Wide-field fundus photograph of an infant. 1240x1240px: 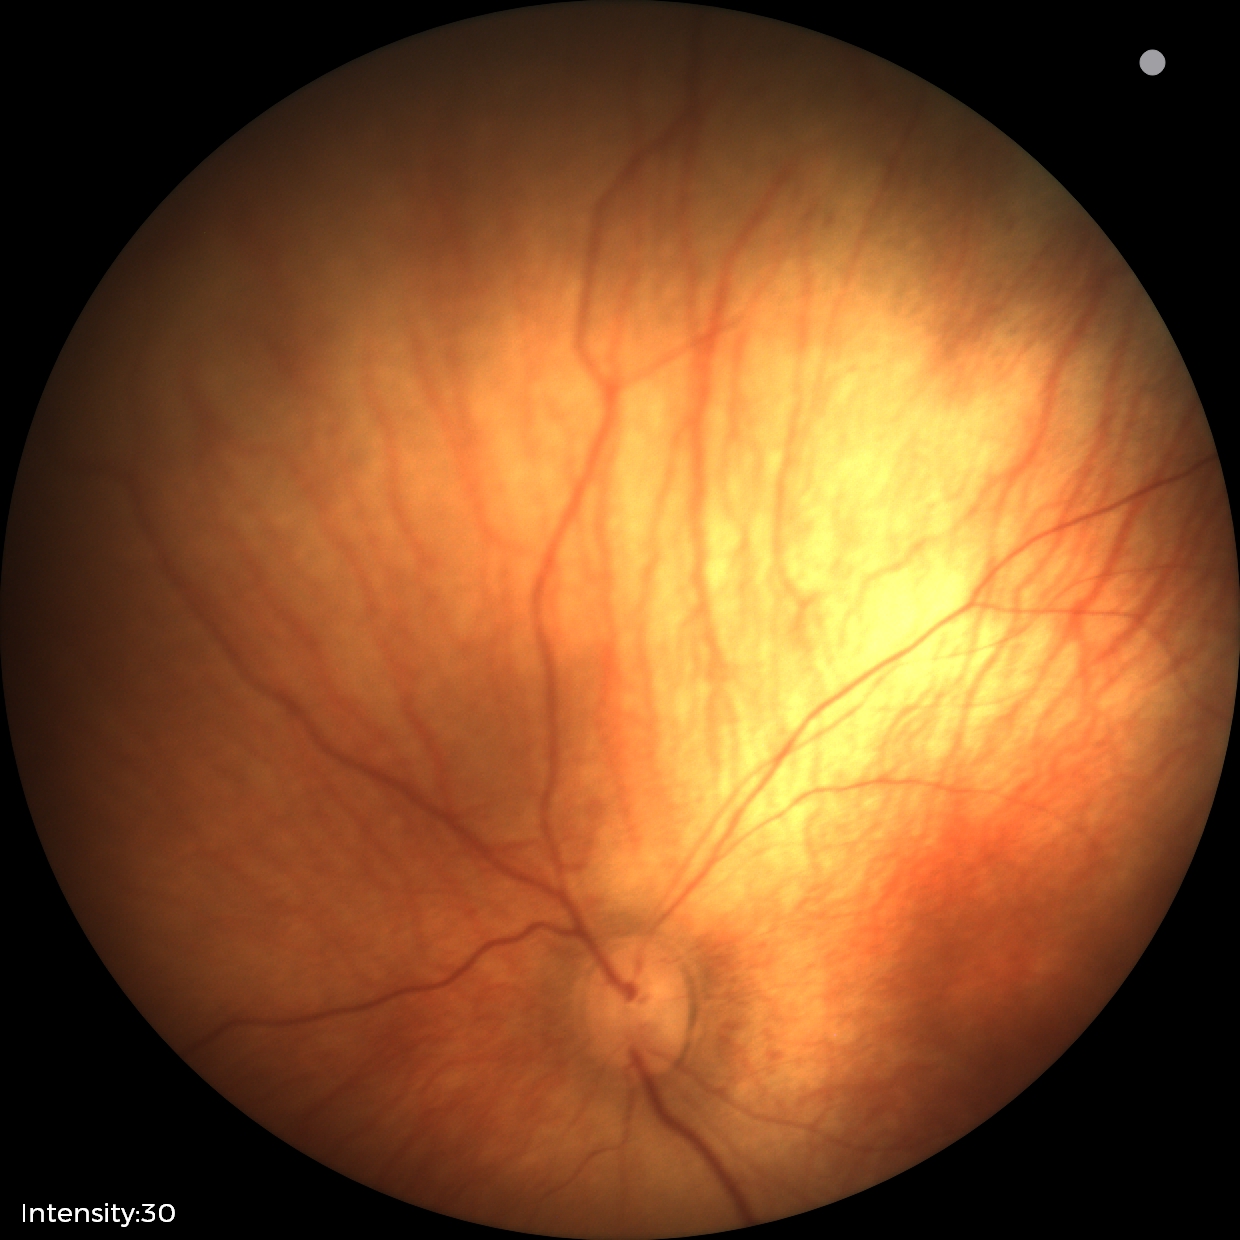

Screening diagnosis: no abnormalities.